Tabletop color fundus camera image:
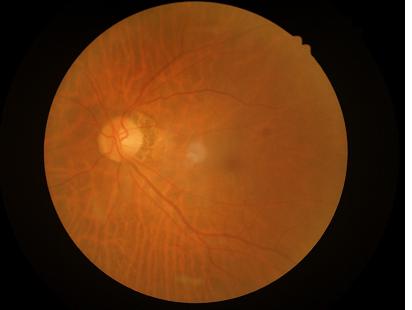
Image quality is adequate for diagnostic use.
The image is blurry.
Good dynamic range.
Even illumination with no color cast.